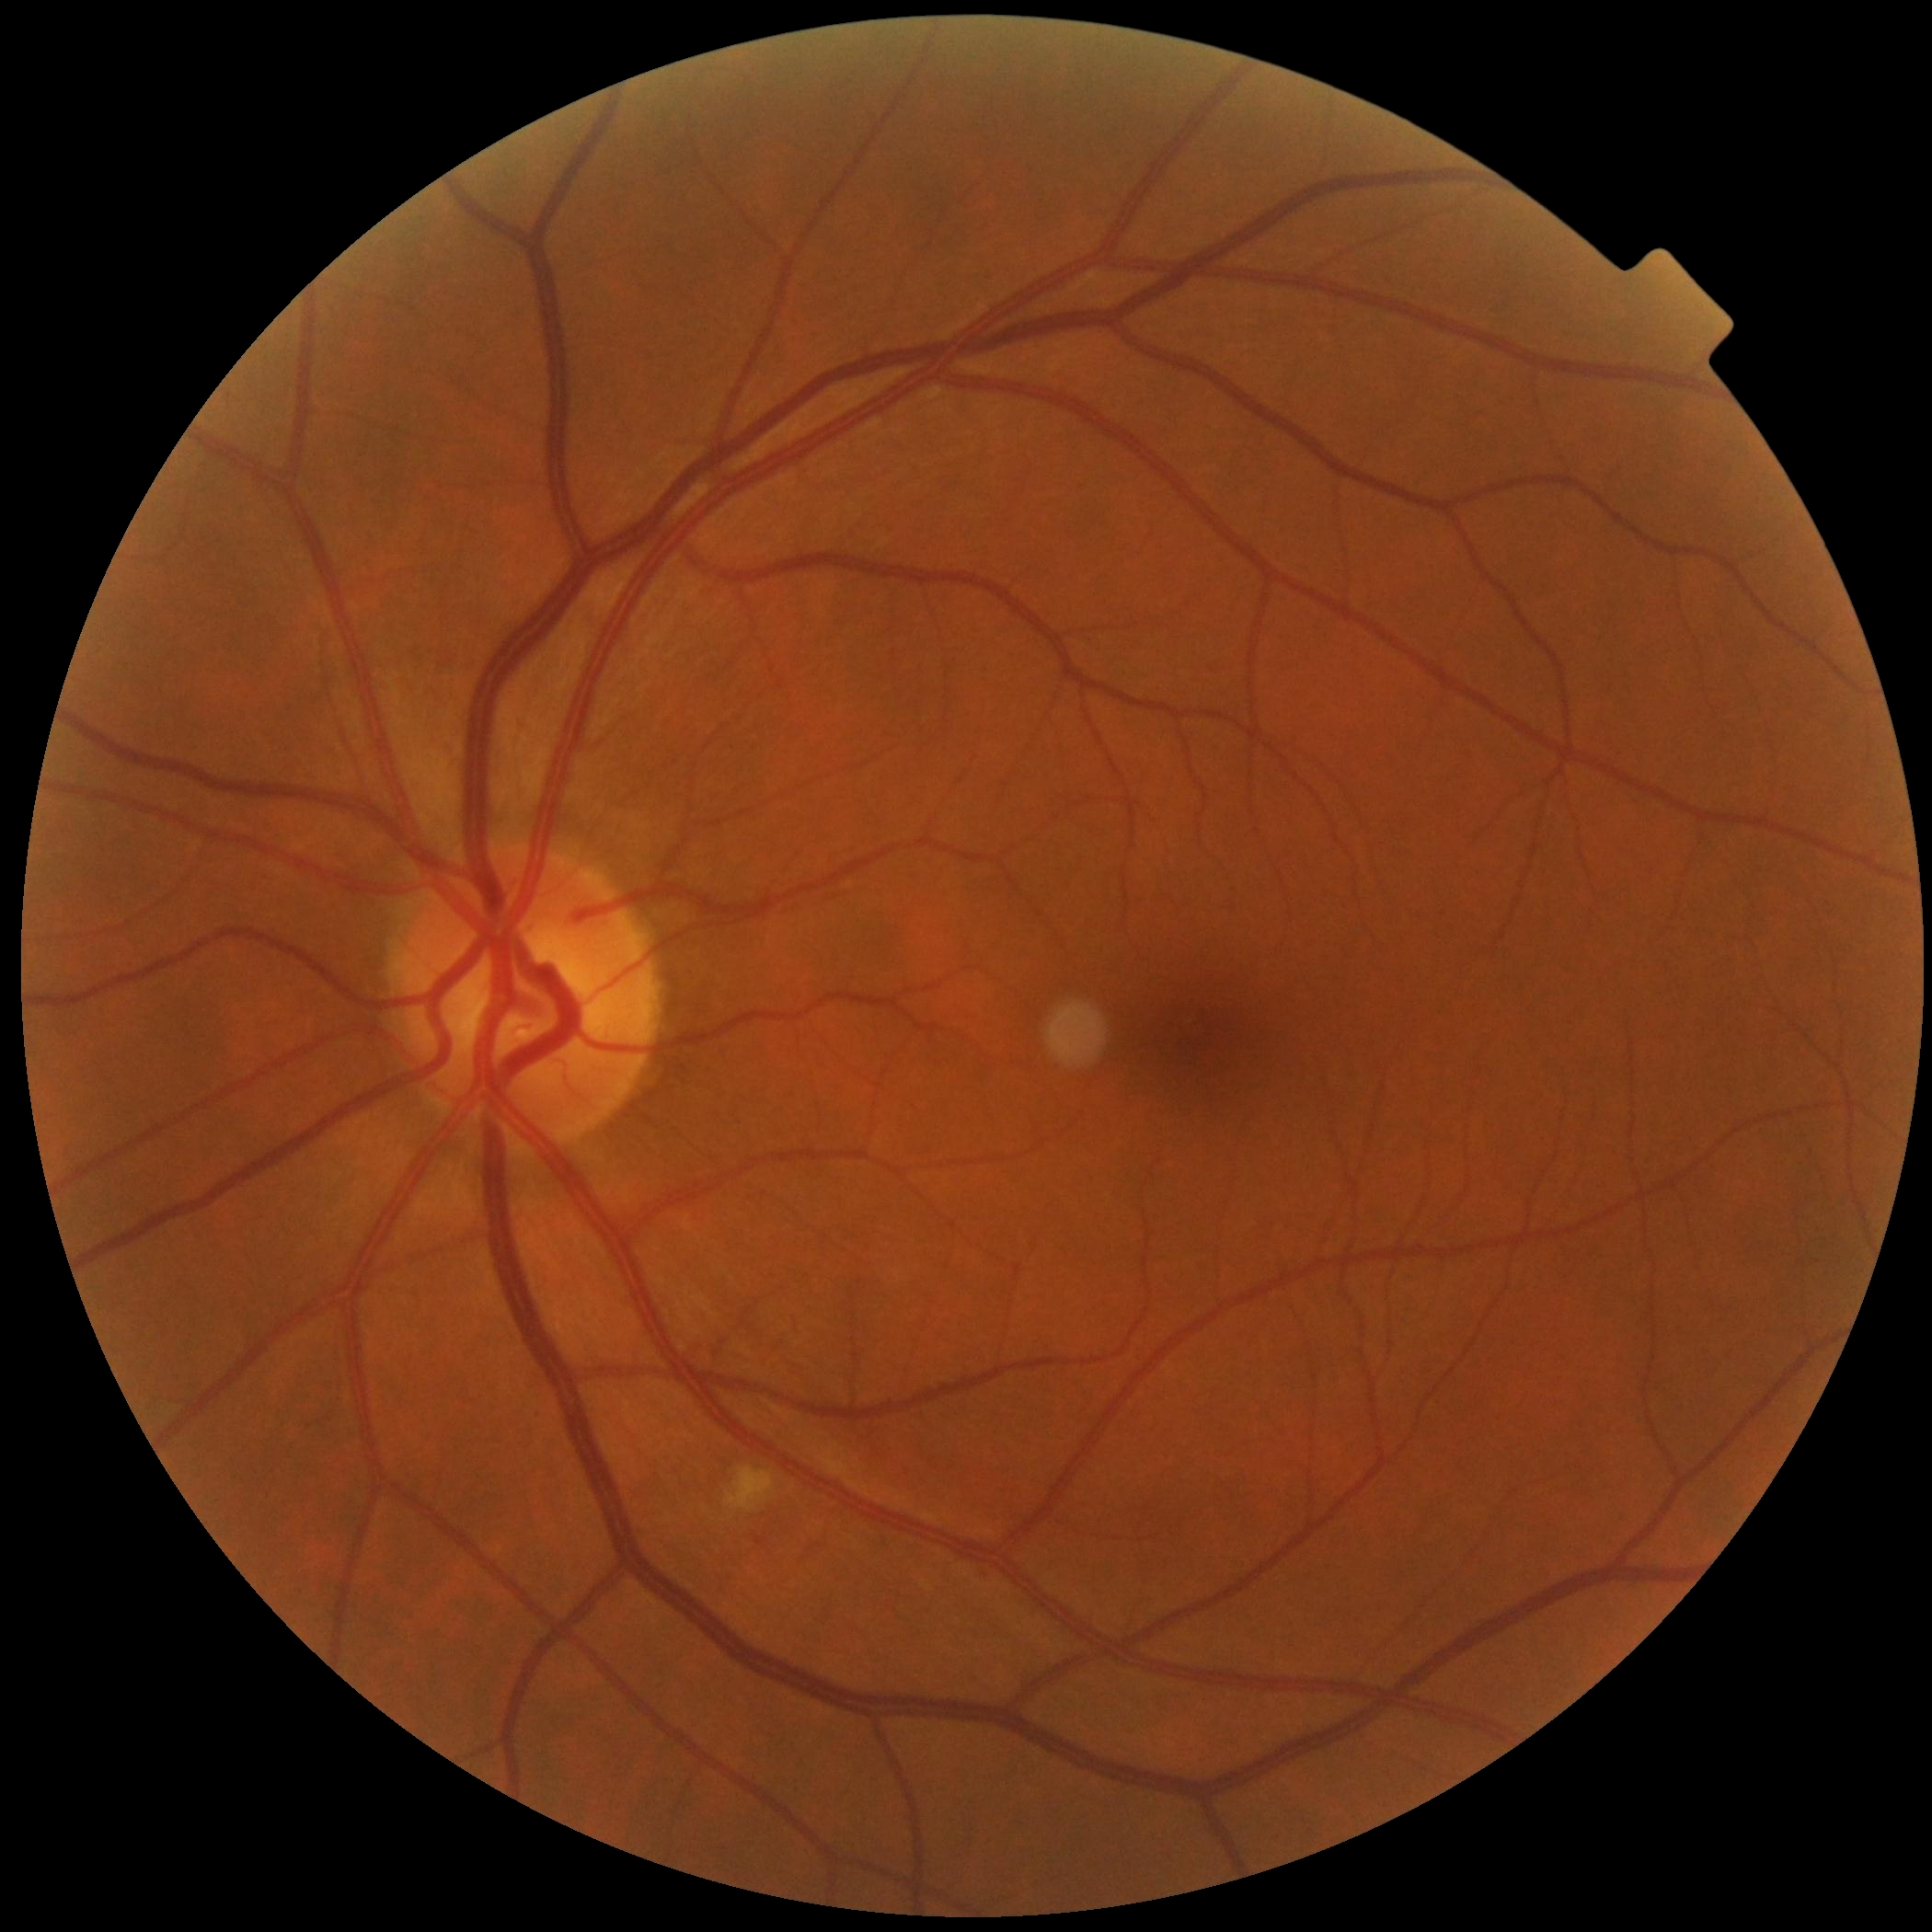 The retinopathy is classified as non-proliferative diabetic retinopathy. Retinopathy: moderate NPDR (grade 2).